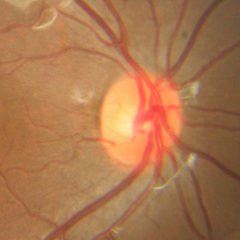
Q: Is glaucoma present?
A: No glaucoma.